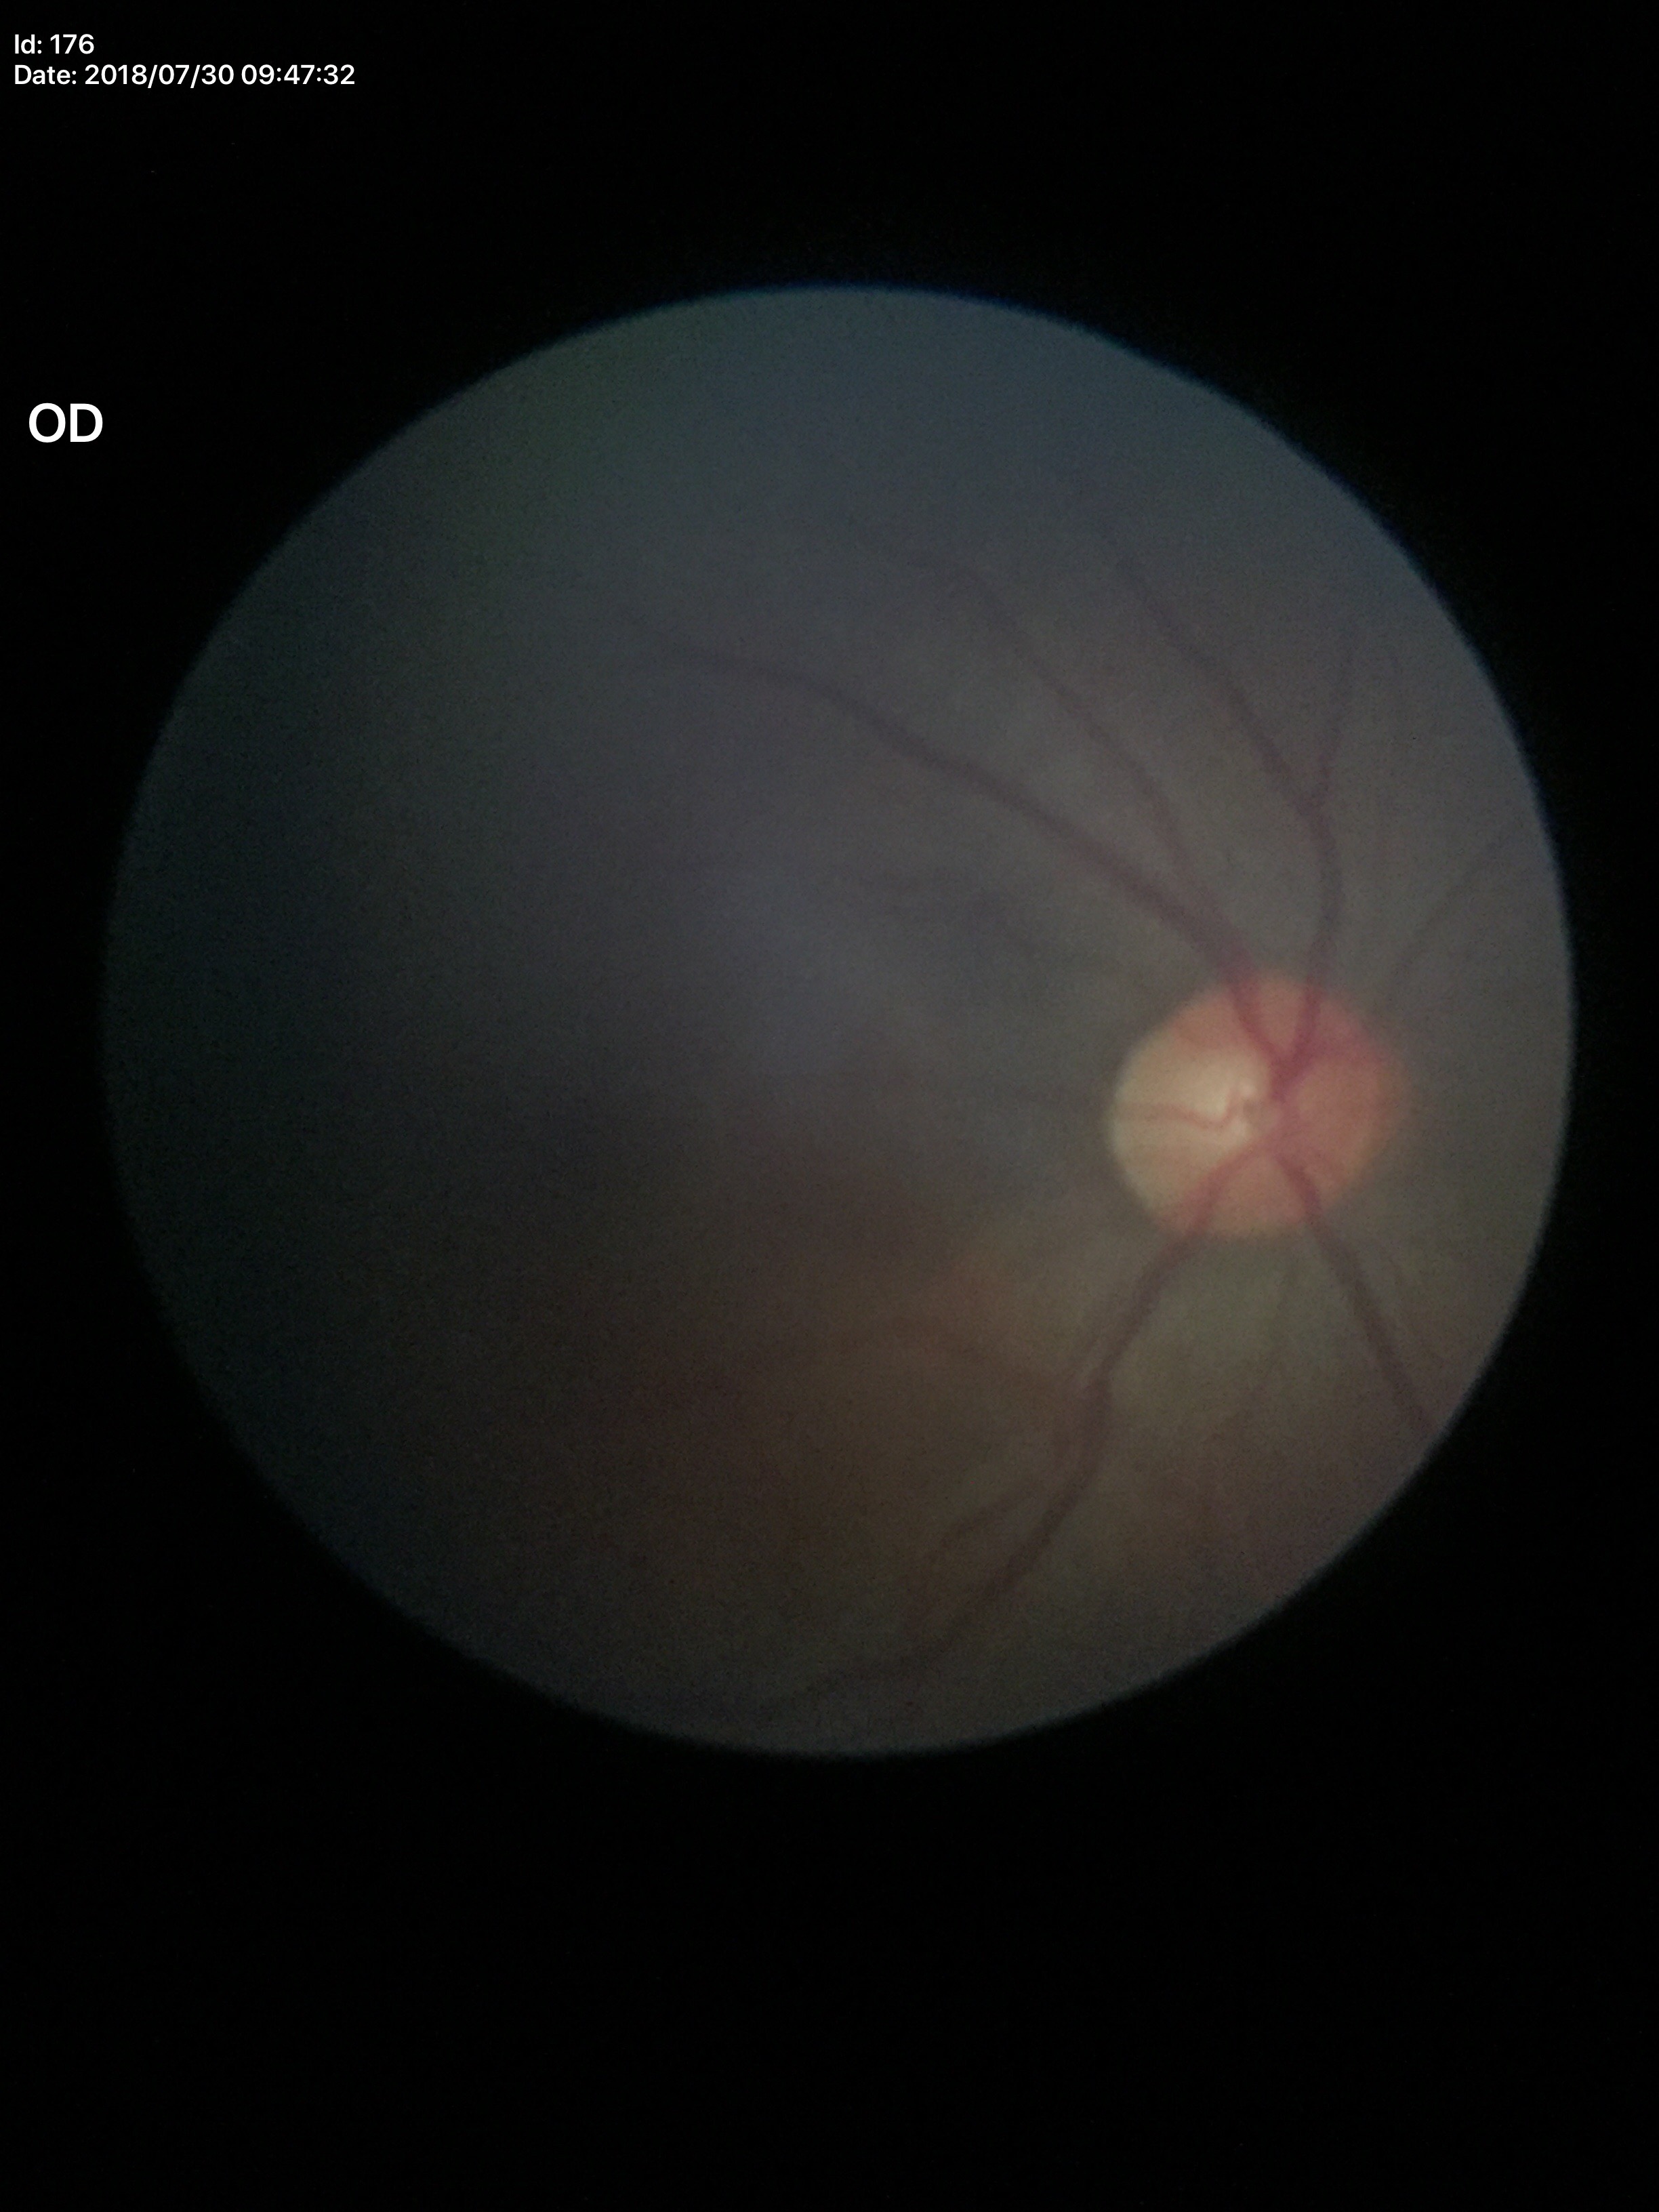 Glaucoma screening impression=no suspicious findings; HCDR=0.47; VCDR=0.49